CFP. 1932x1932px. 45-degree field of view.
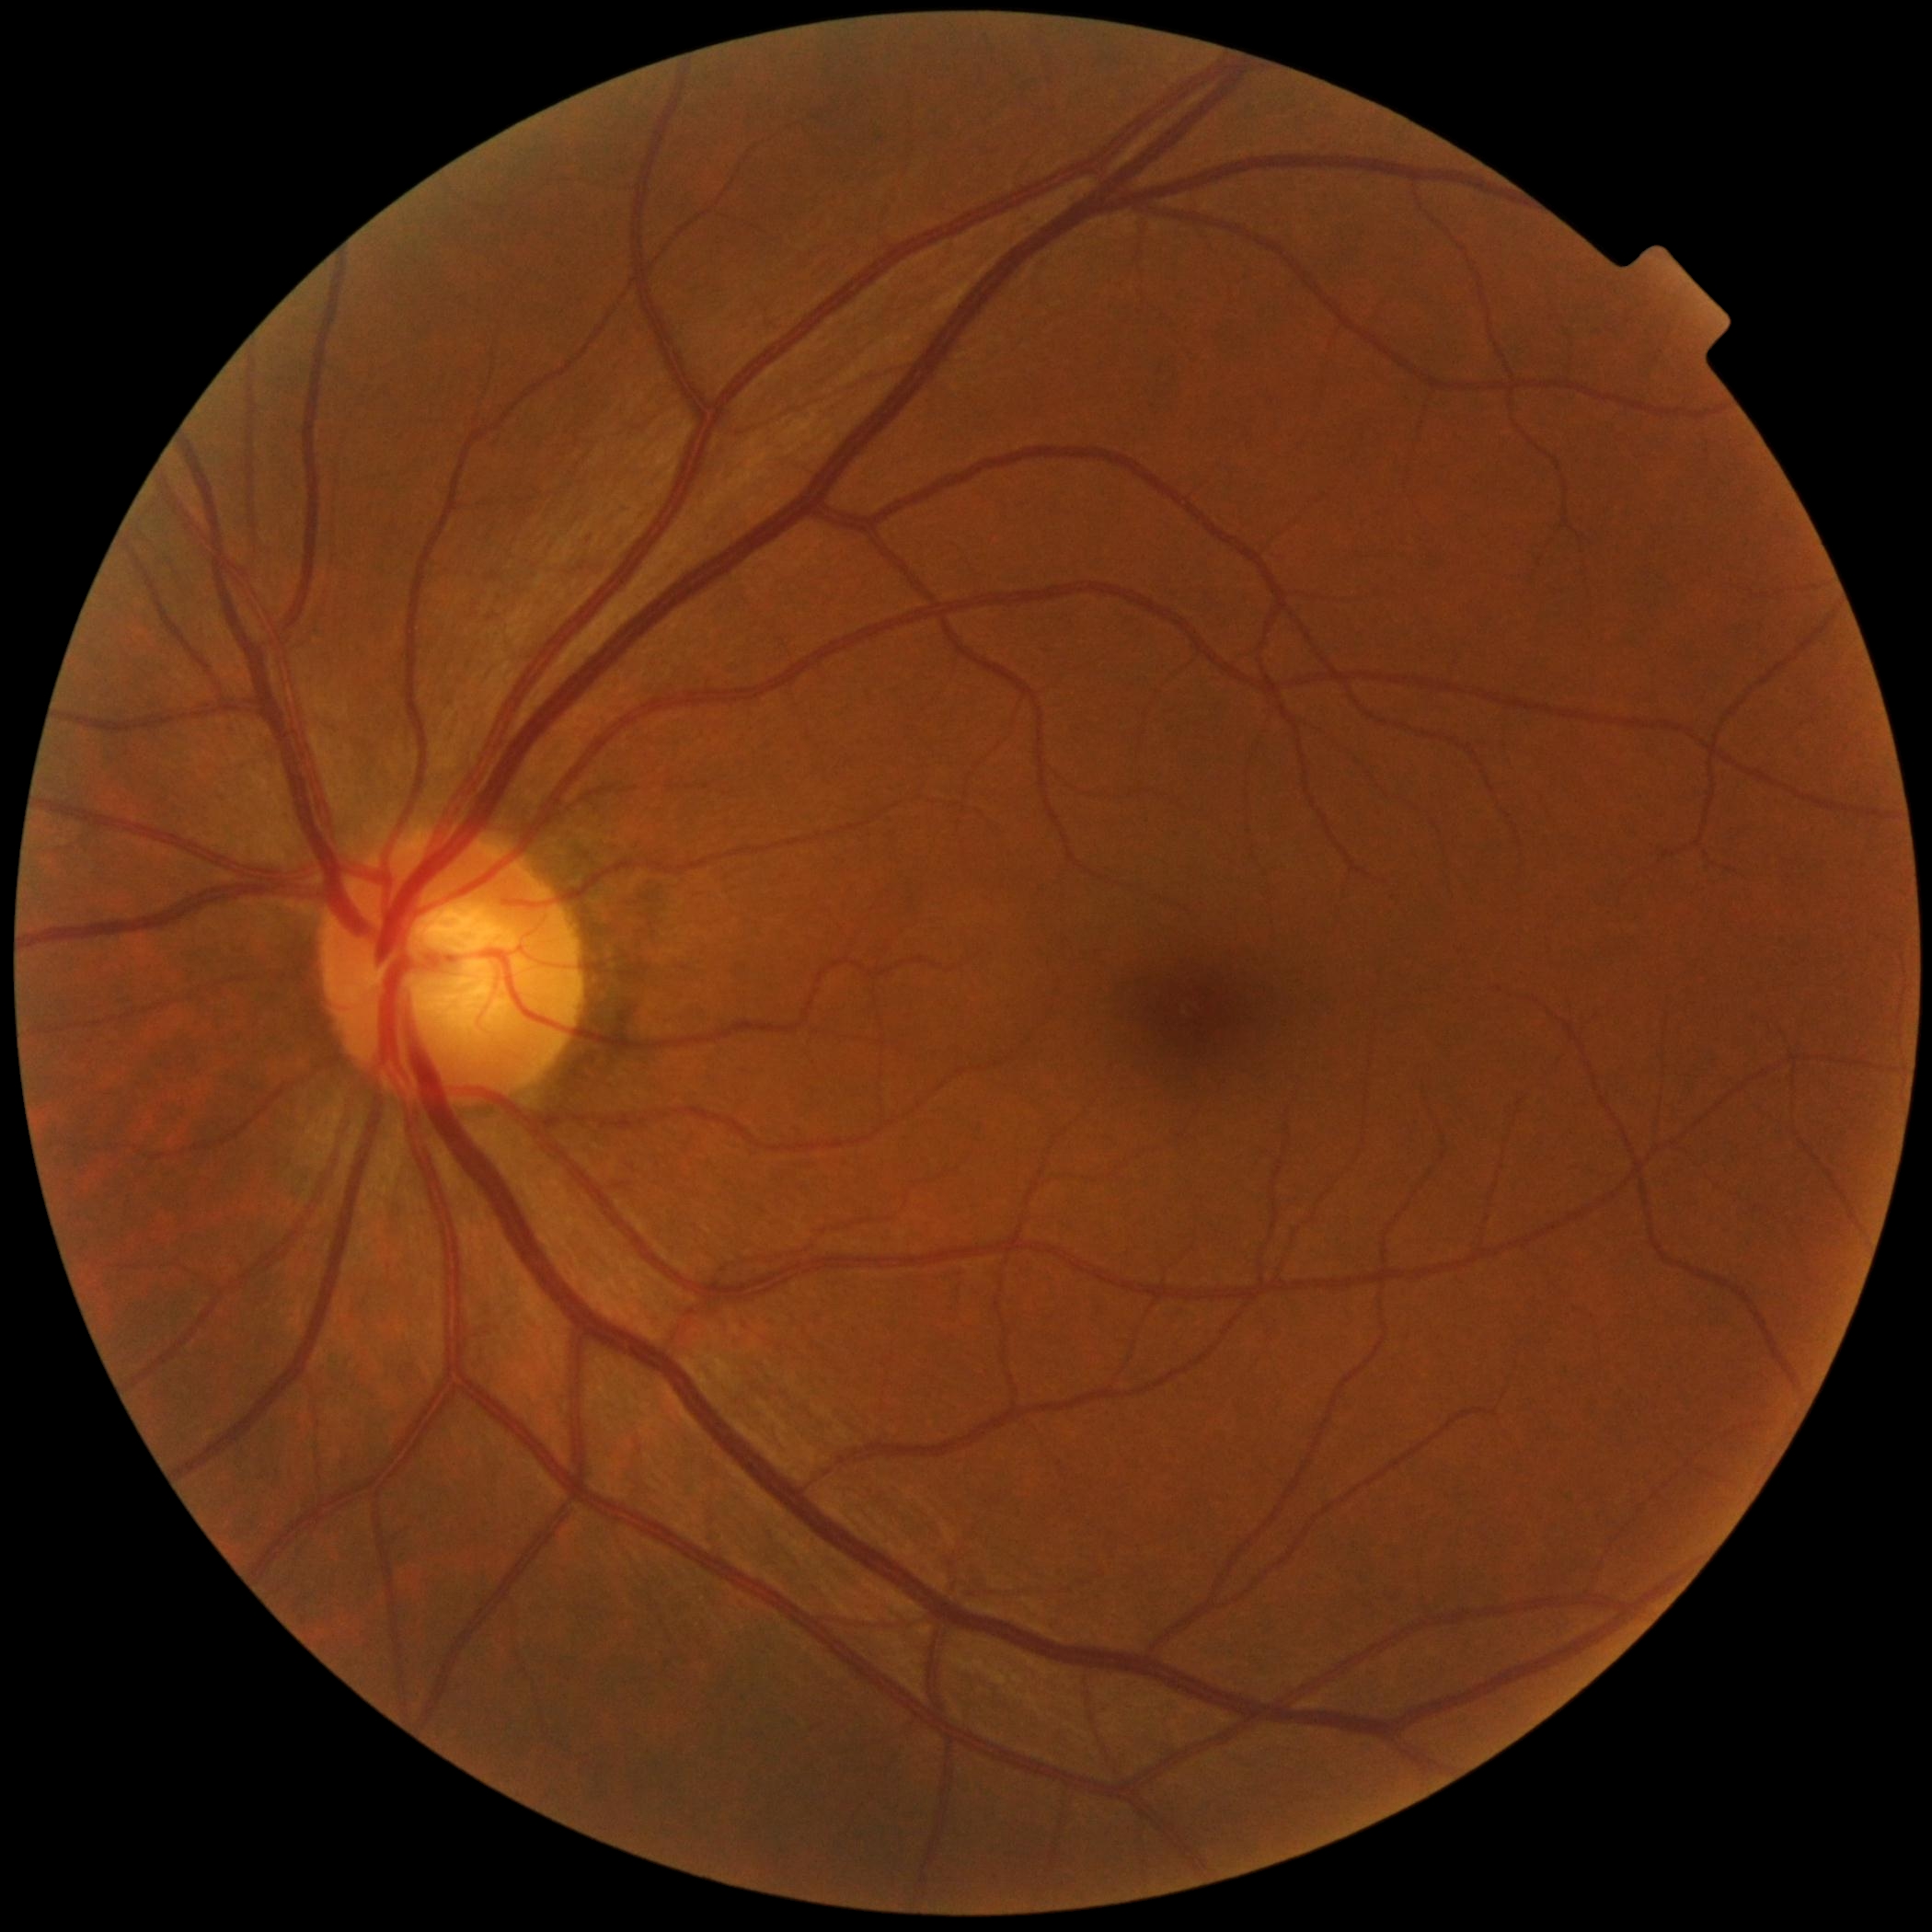 Findings:
– DR grade — 0 (no apparent retinopathy)